Modified Davis classification.
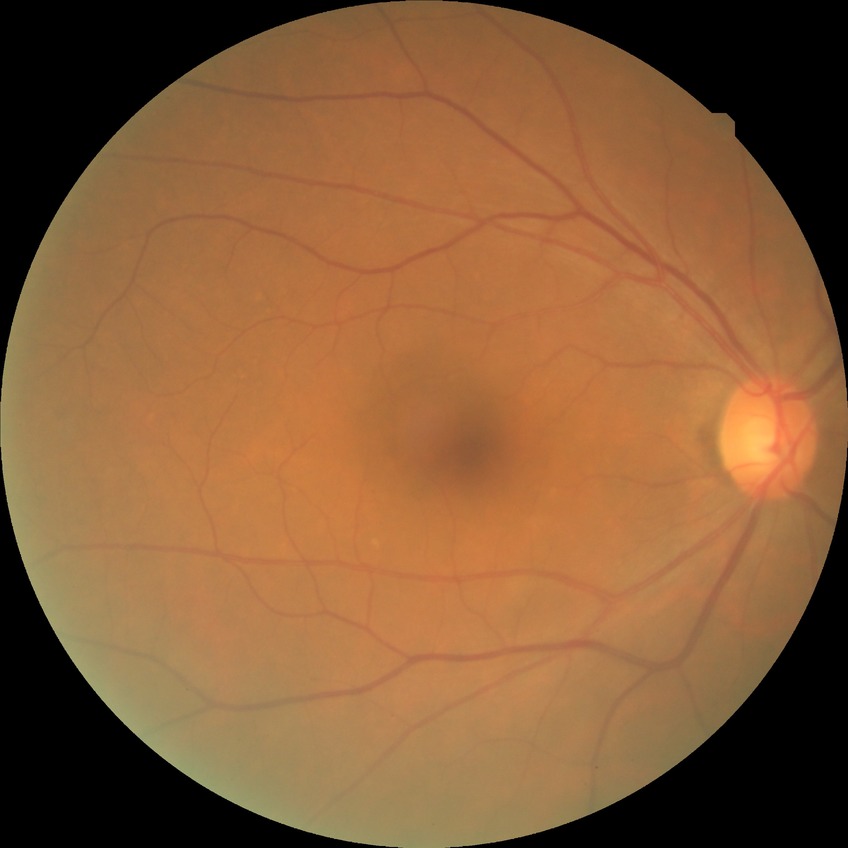

Findings:
* DR impression: negative for DR
* Davis stage: NDR